CFP:
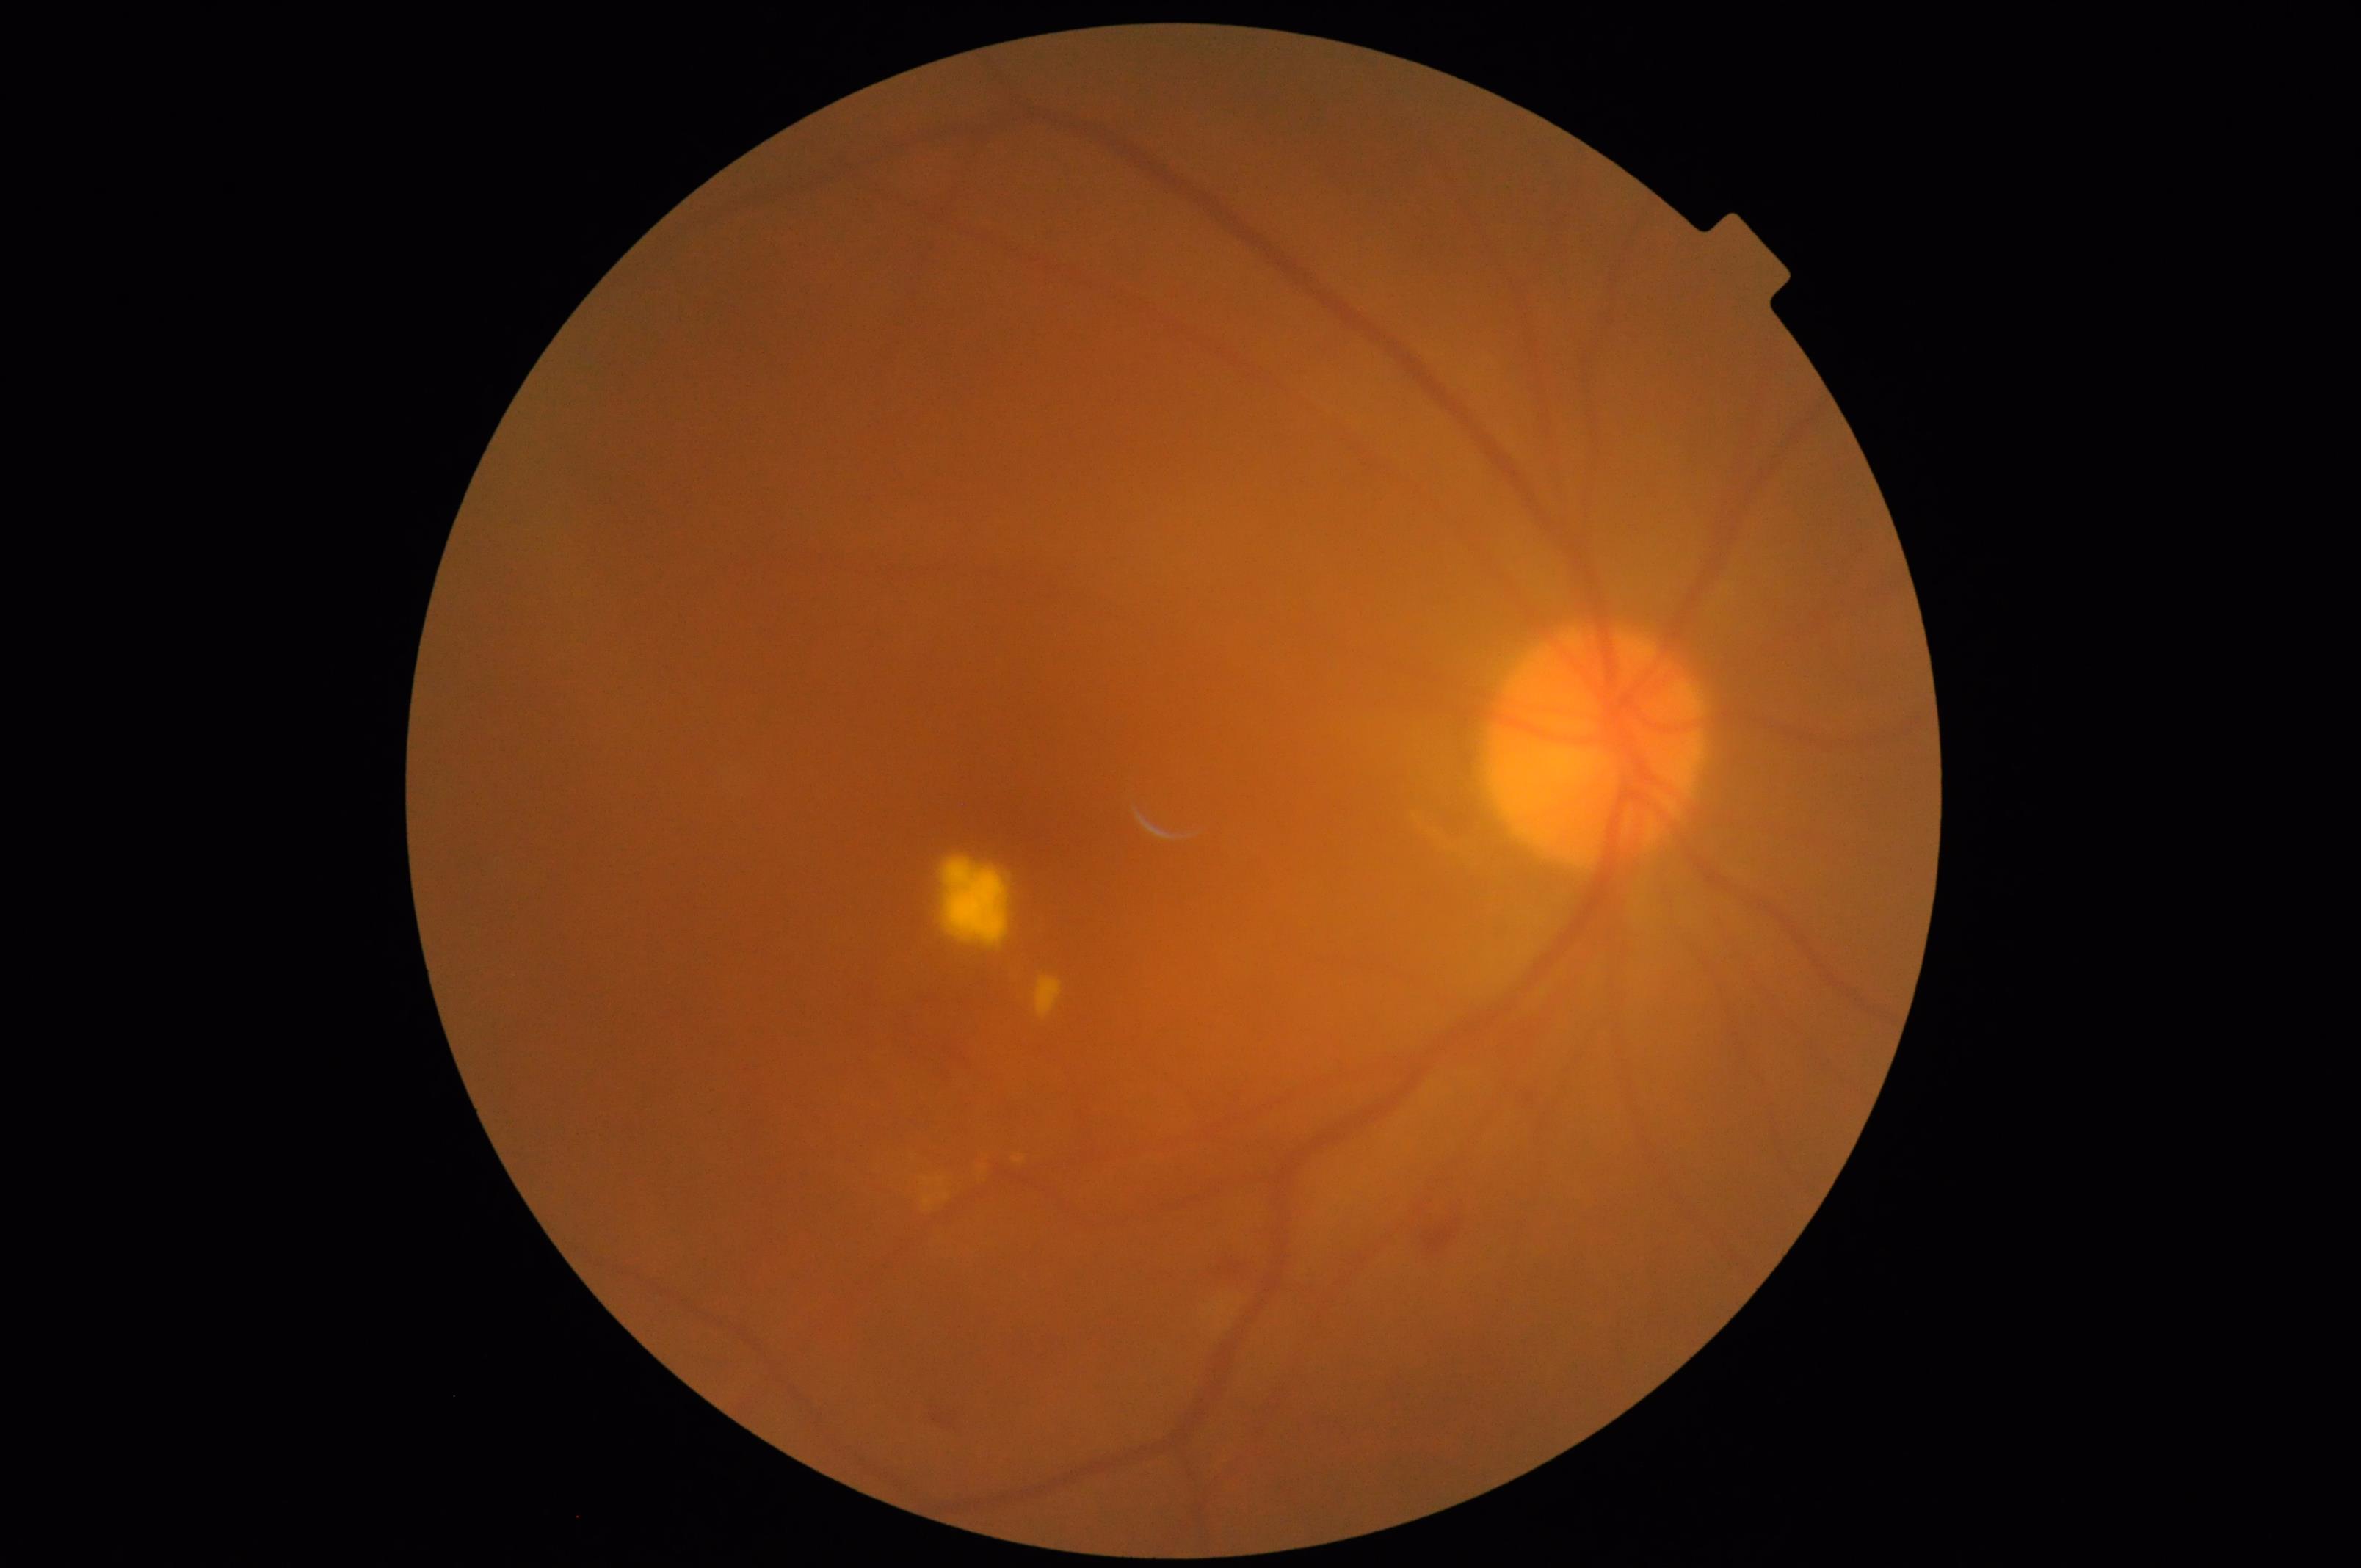

Out of focus; structures are indistinct.
Contrast is good.
Image quality is suboptimal.
No over- or under-exposure.